Phoenix ICON, 100° FOV; wide-field fundus image from infant ROP screening.
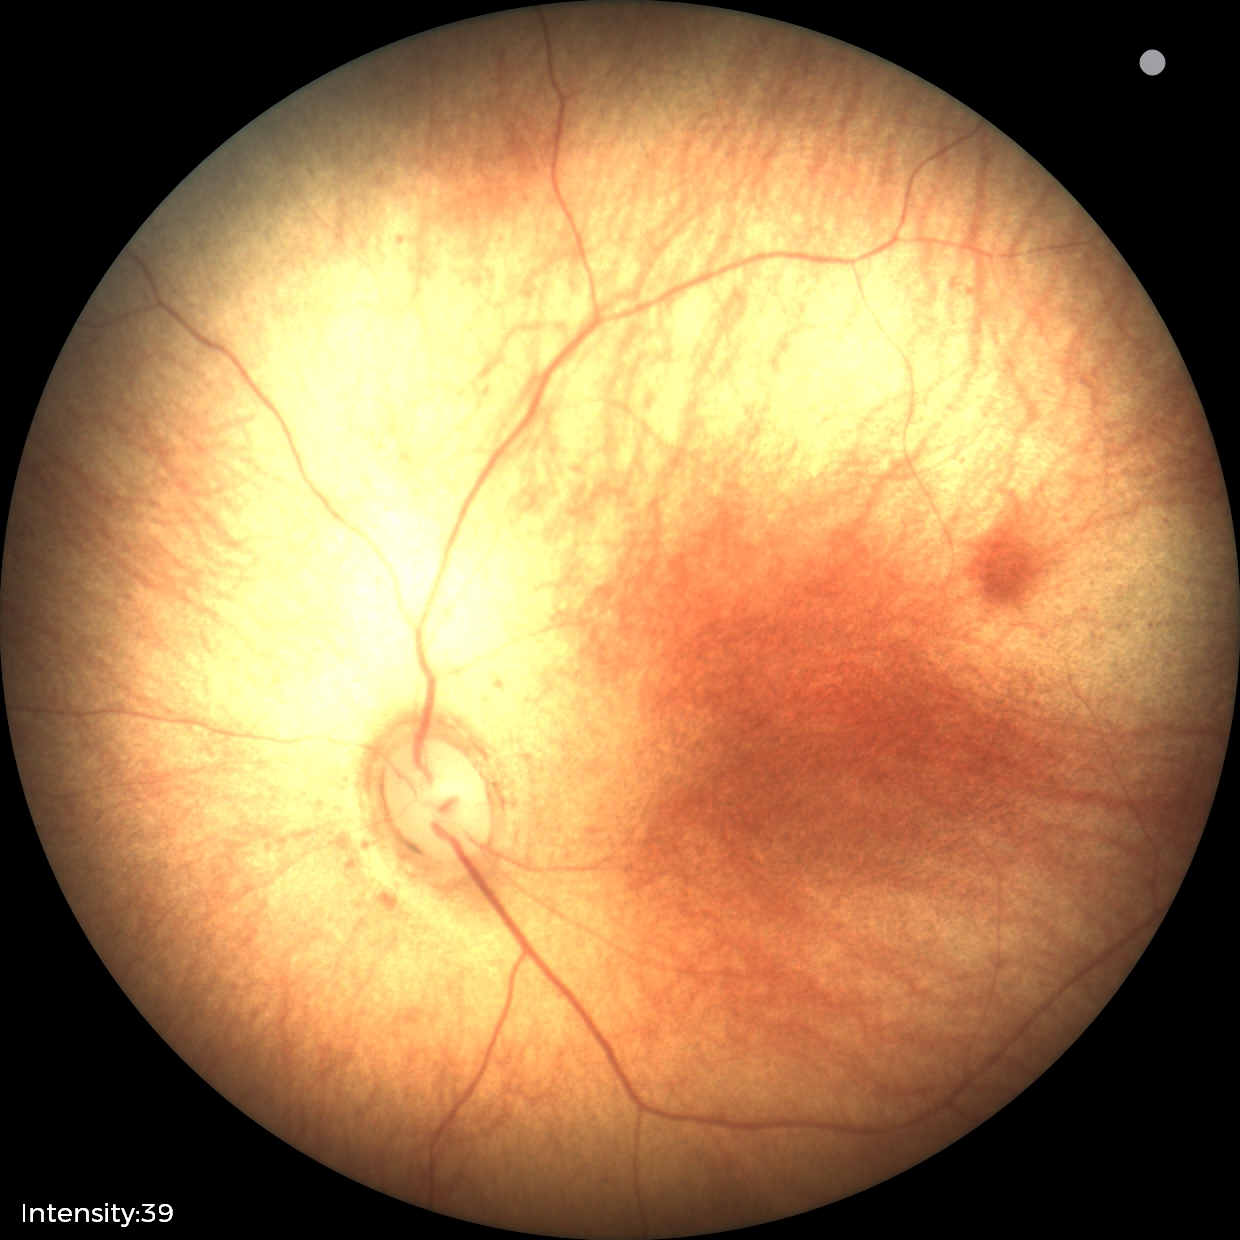 Screening examination with no abnormal retinal findings.